Camera: Clarity RetCam 3 (130° FOV) · wide-field contact fundus photograph of an infant
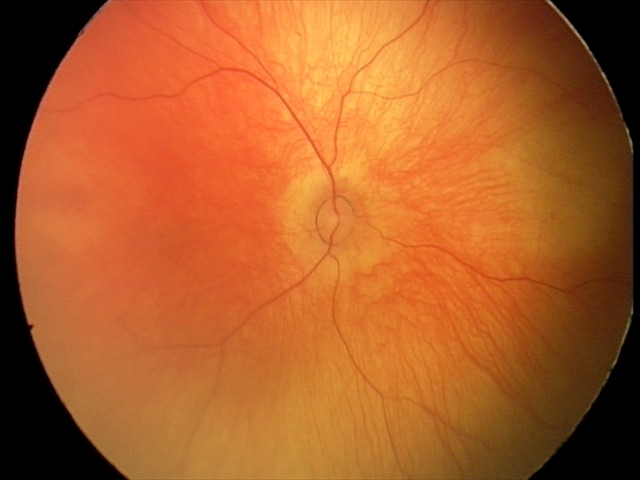
Finding = physiological appearance.